DR severity per modified Davis staging — 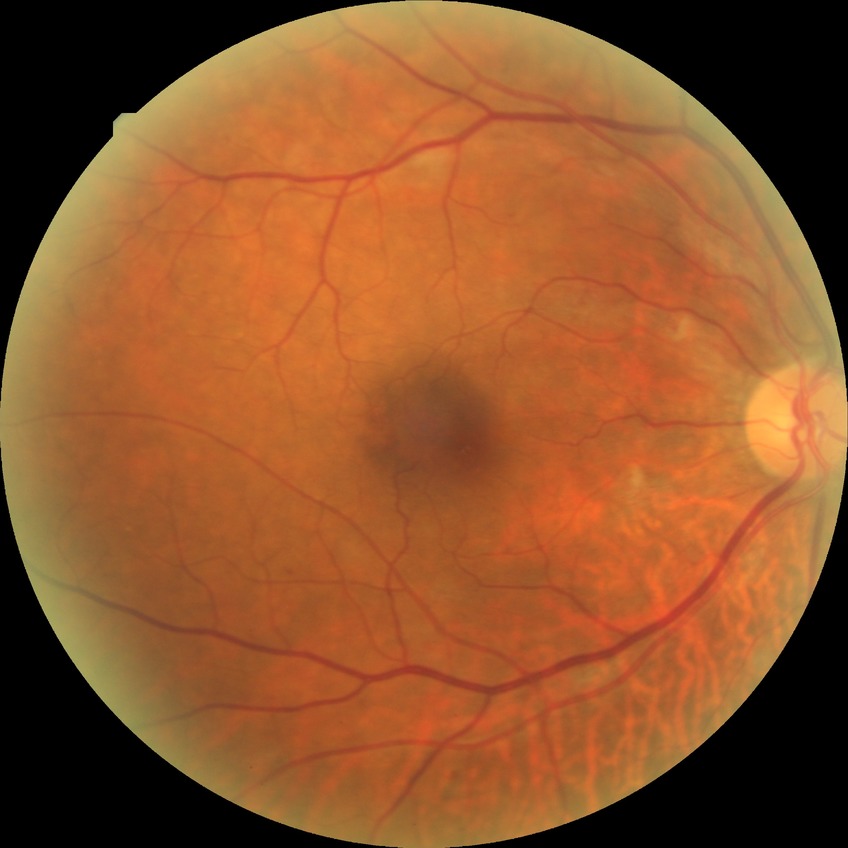
  davis_grade: pre-proliferative diabetic retinopathy (PPDR)